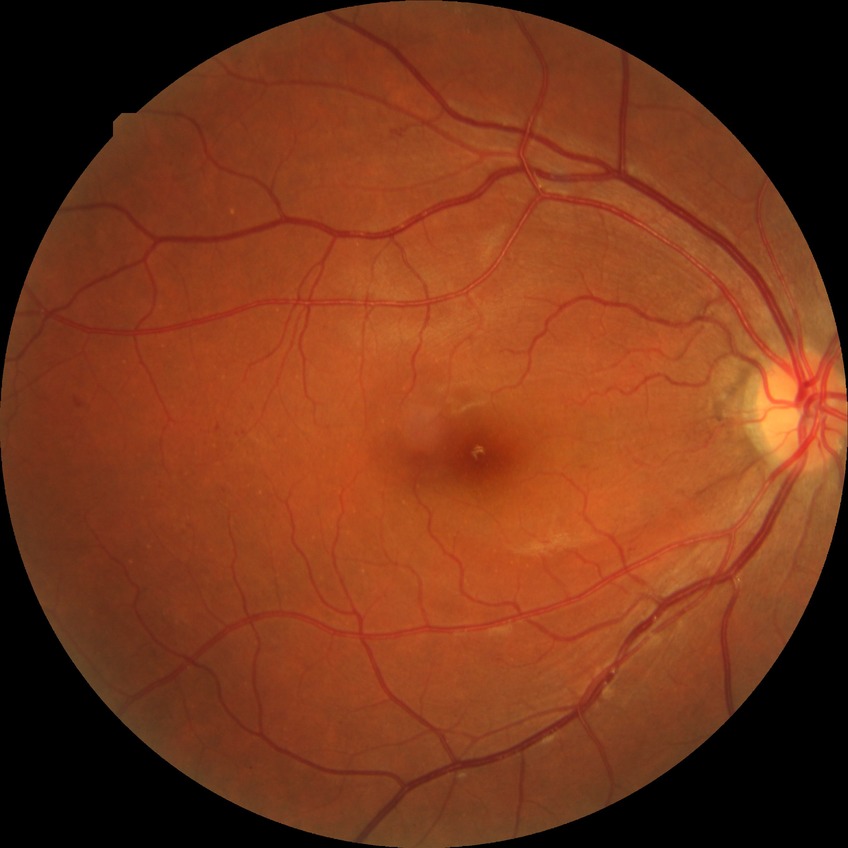

  davis_grade: SDR